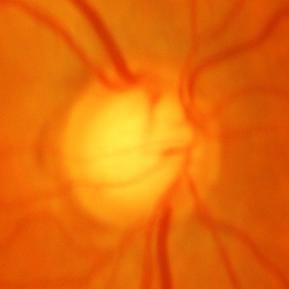

There is evidence of glaucomatous changes.